1920x1440px — 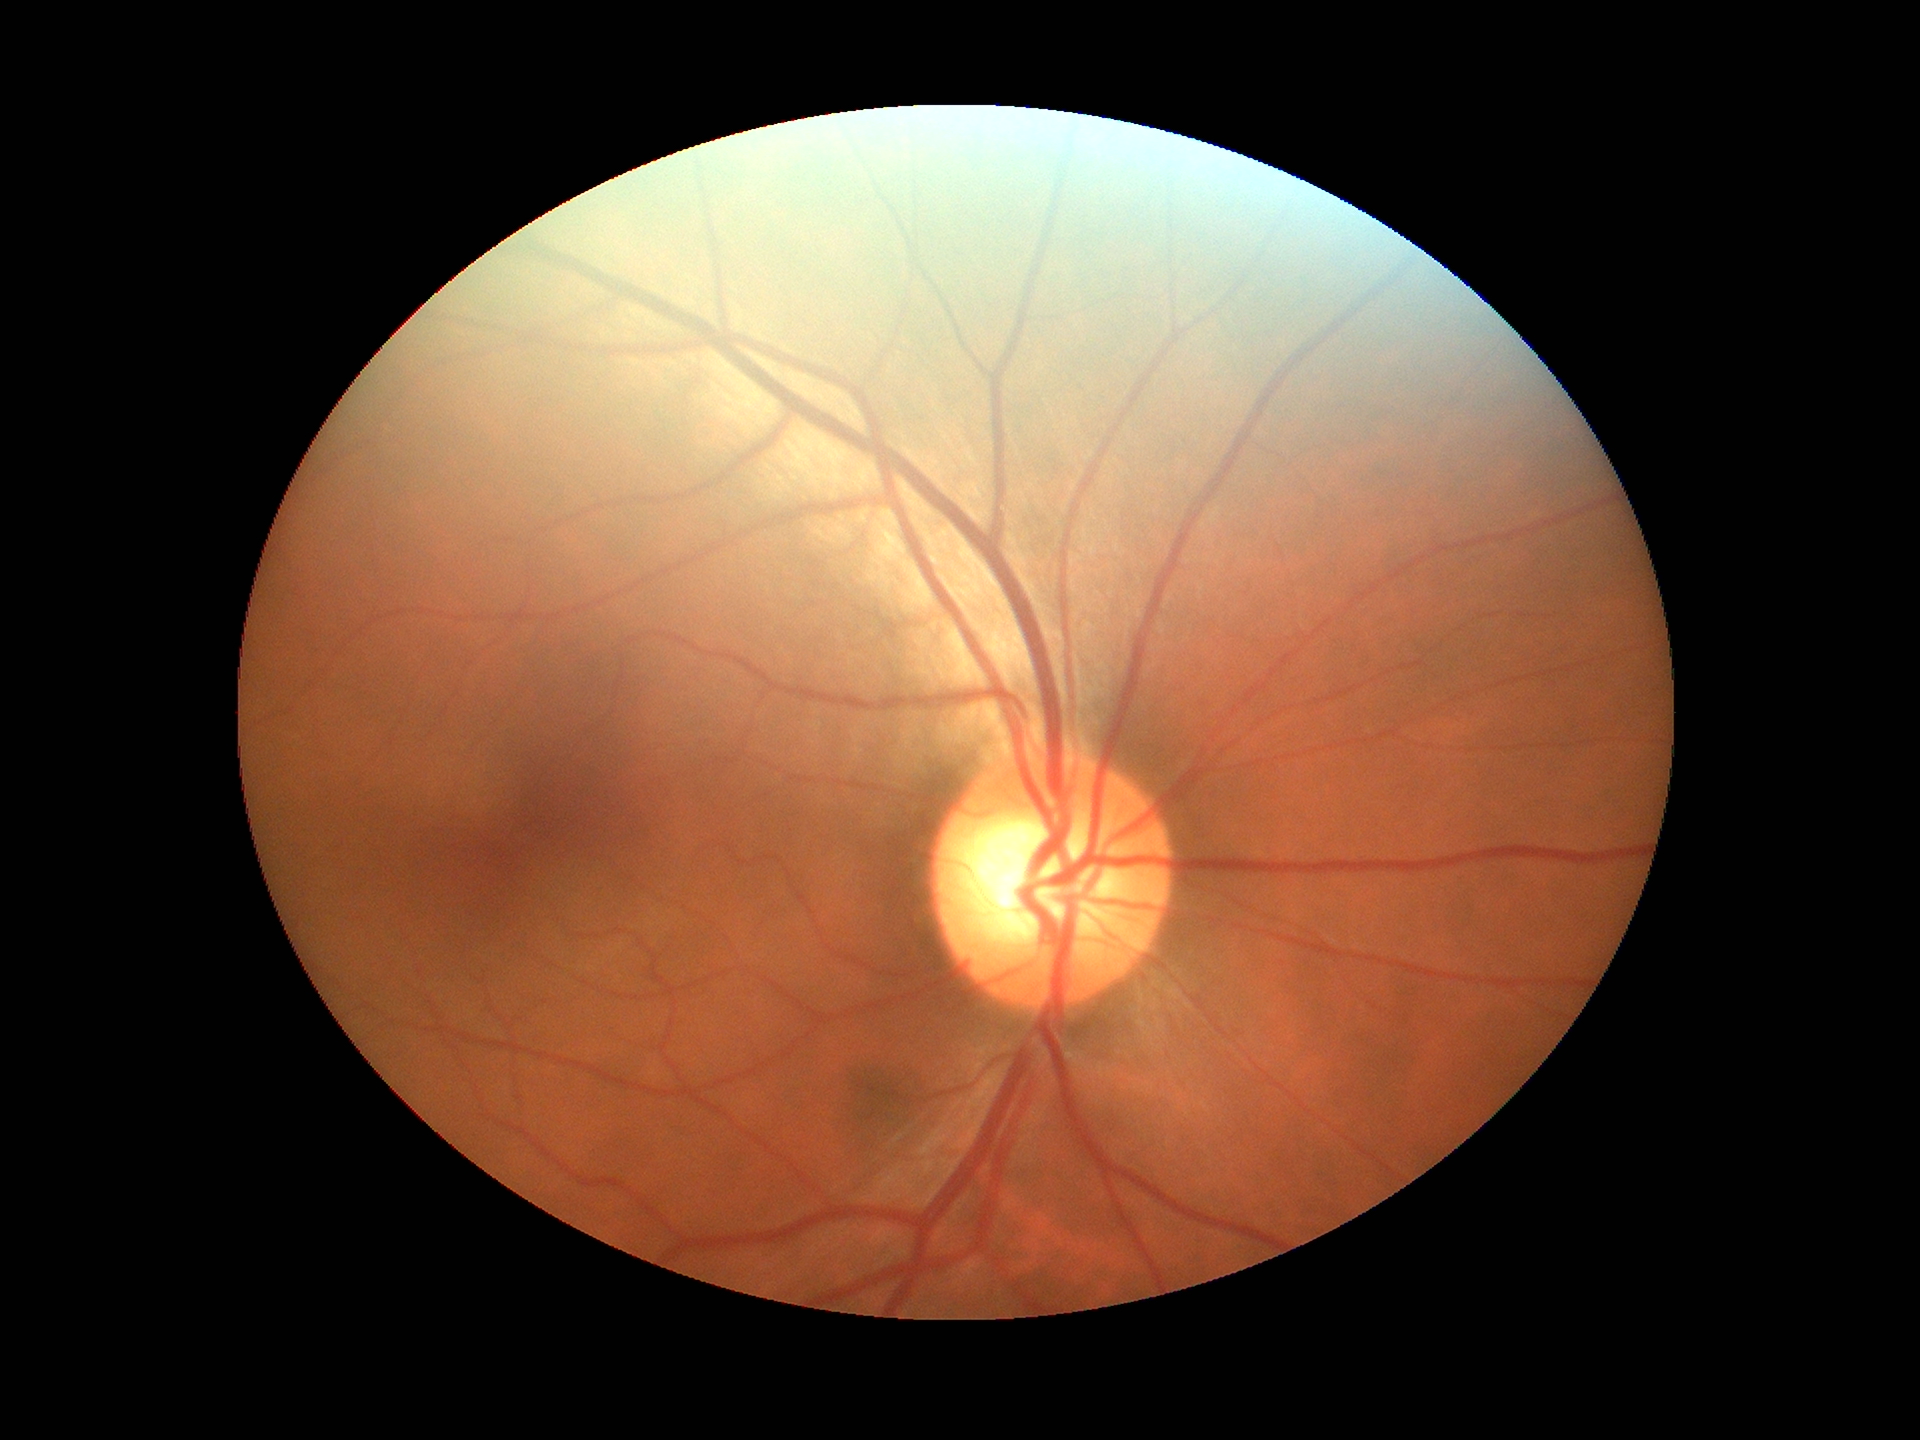

Glaucoma impression: negative | vertical CDR: 0.56.